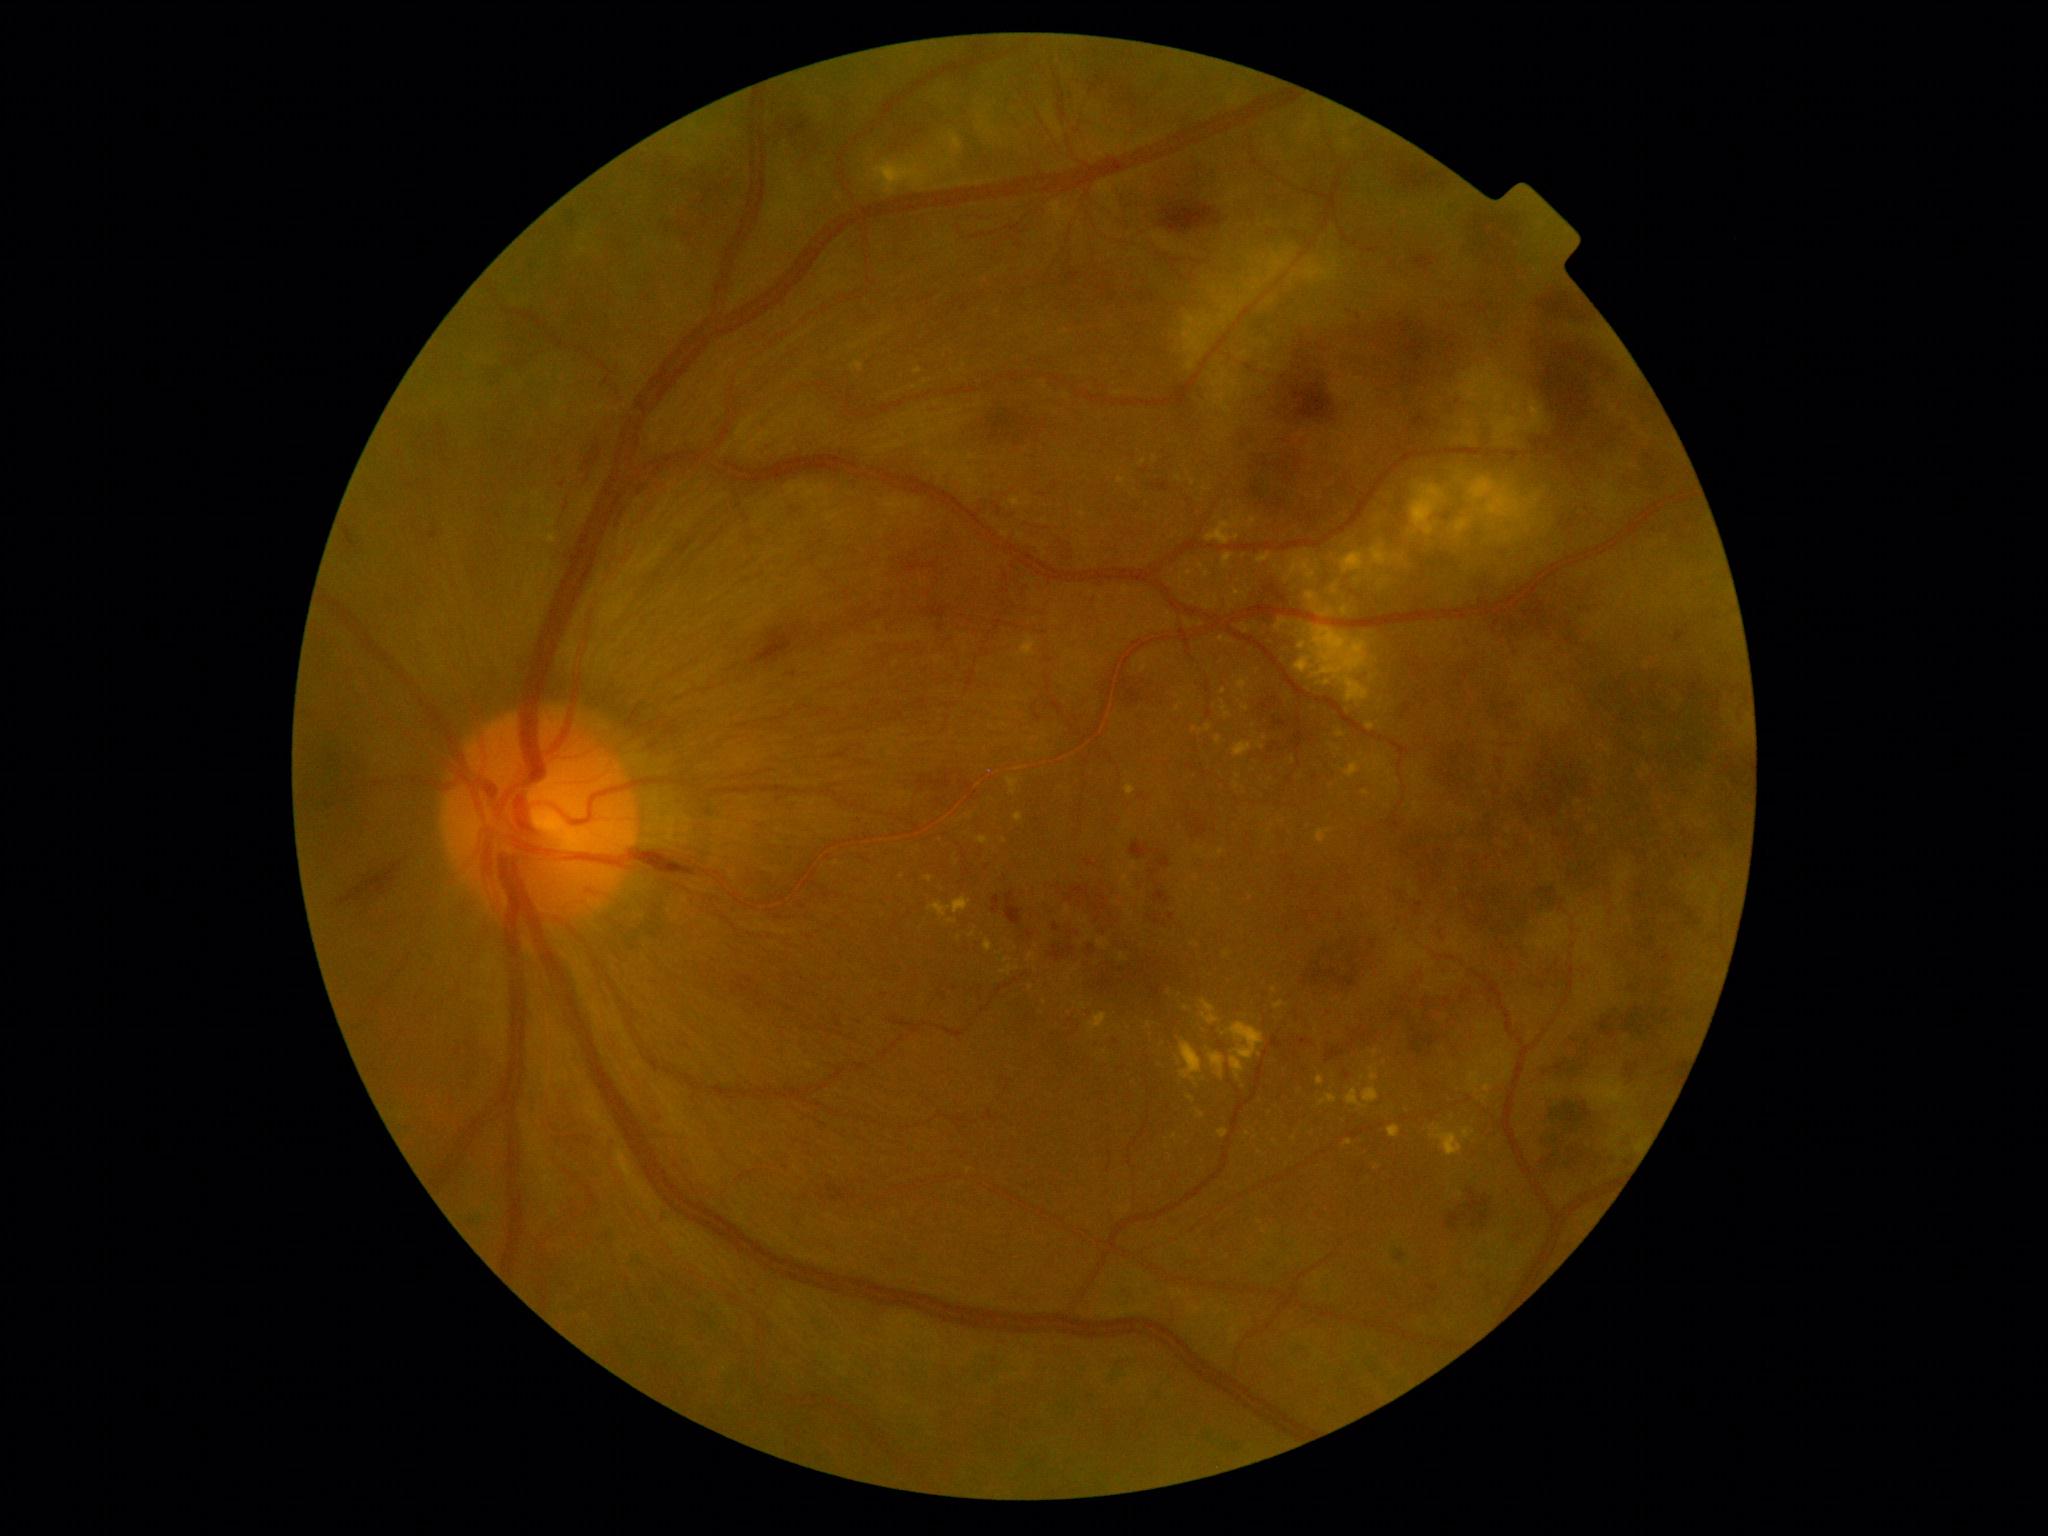

Retinopathy is 4/4; proliferative diabetic retinopathy
Lesions identified (partial list):
hemorrhages (continued): (x1=759, y1=405, x2=780, y2=431) | (x1=562, y1=424, x2=615, y2=521) | (x1=1663, y1=1060, x2=1687, y2=1088) | (x1=1064, y1=268, x2=1085, y2=289) | (x1=343, y1=526, x2=357, y2=551) | (x1=1618, y1=1060, x2=1648, y2=1094) | (x1=549, y1=1095, x2=614, y2=1158) | (x1=663, y1=477, x2=1082, y2=763) | (x1=501, y1=321, x2=568, y2=372) | (x1=1531, y1=1097, x2=1638, y2=1184) | (x1=1385, y1=156, x2=1458, y2=195) | (x1=1246, y1=583, x2=1292, y2=630) | (x1=621, y1=490, x2=766, y2=617)
Smaller hemorrhages around (x=440, y=427)
hard exudates (continued): (x1=1133, y1=862, x2=1137, y2=871) | (x1=1014, y1=813, x2=1024, y2=822) | (x1=1223, y1=553, x2=1234, y2=570) | (x1=1220, y1=636, x2=1236, y2=644) | (x1=1484, y1=1078, x2=1494, y2=1093) | (x1=1572, y1=1064, x2=1657, y2=1177) | (x1=939, y1=132, x2=963, y2=156) | (x1=1233, y1=742, x2=1253, y2=758) | (x1=1118, y1=477, x2=1127, y2=484)
Smaller hard exudates around (x=1169, y=614) | (x=1221, y=852) | (x=1275, y=1142) | (x=918, y=371) | (x=1169, y=993) | (x=1031, y=988) | (x=1294, y=760) | (x=1274, y=990) | (x=1005, y=725)